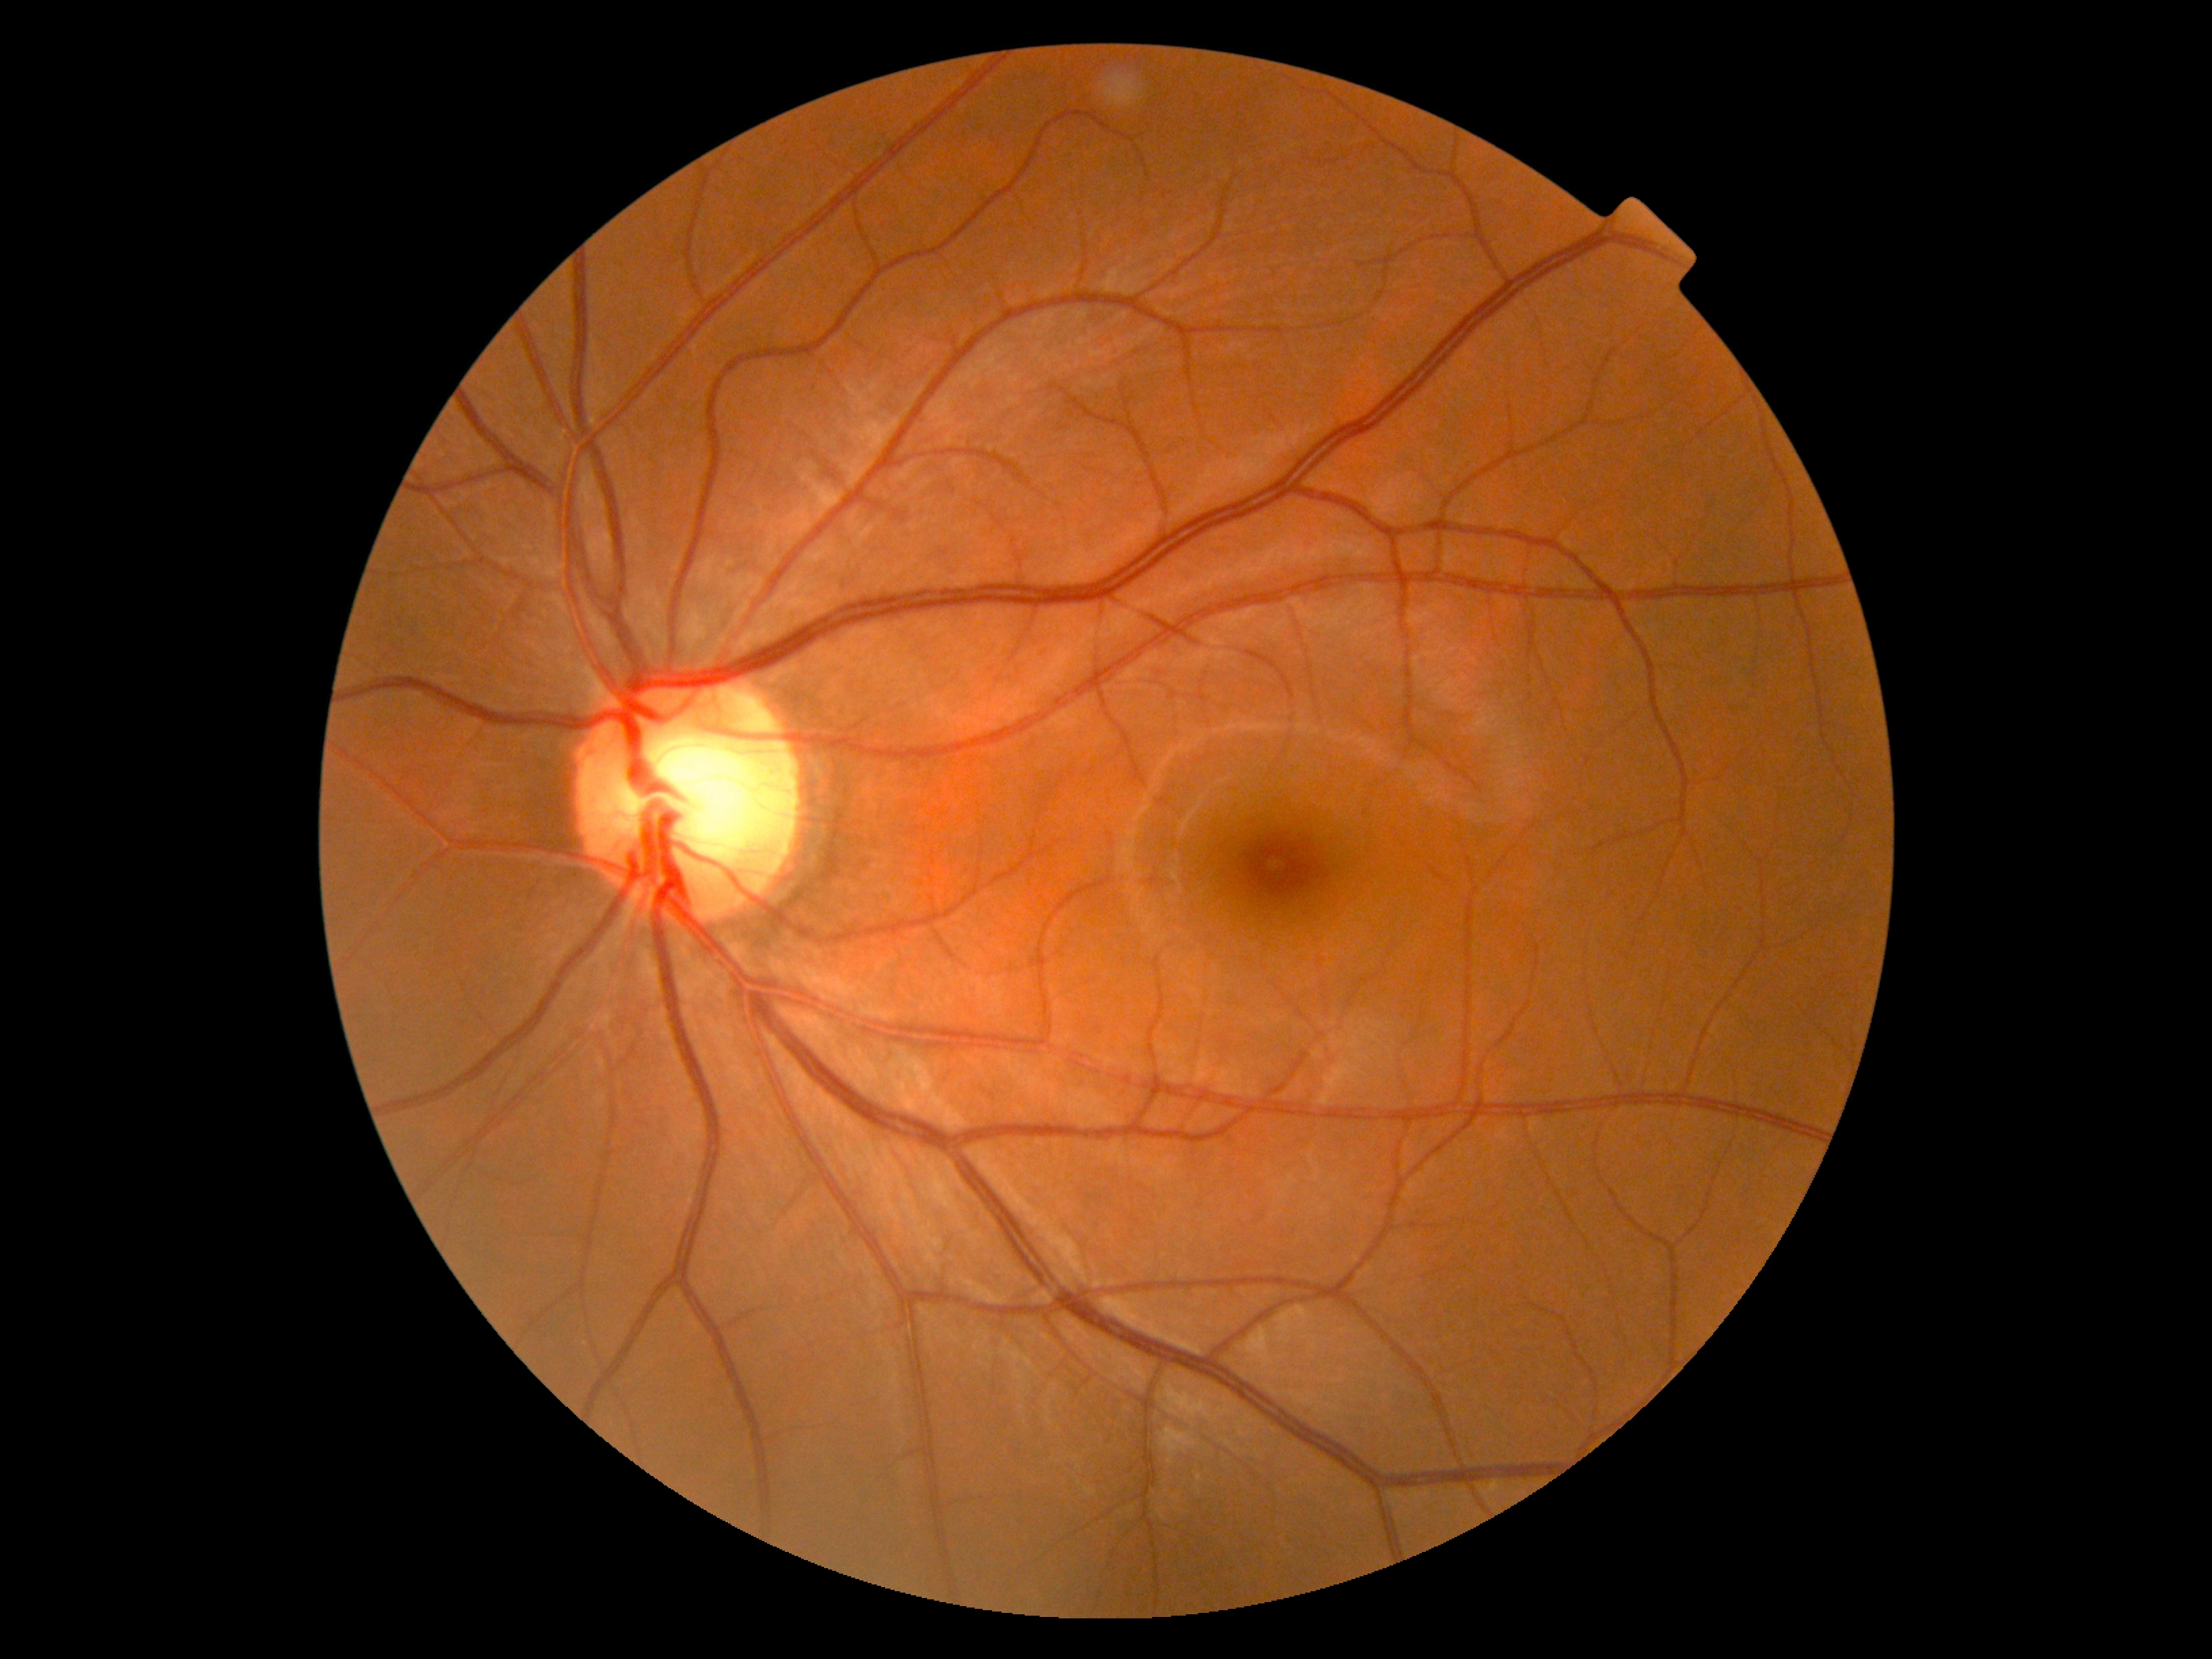

{"dr_impression": "no signs of DR", "dr_grade": "0/4"}